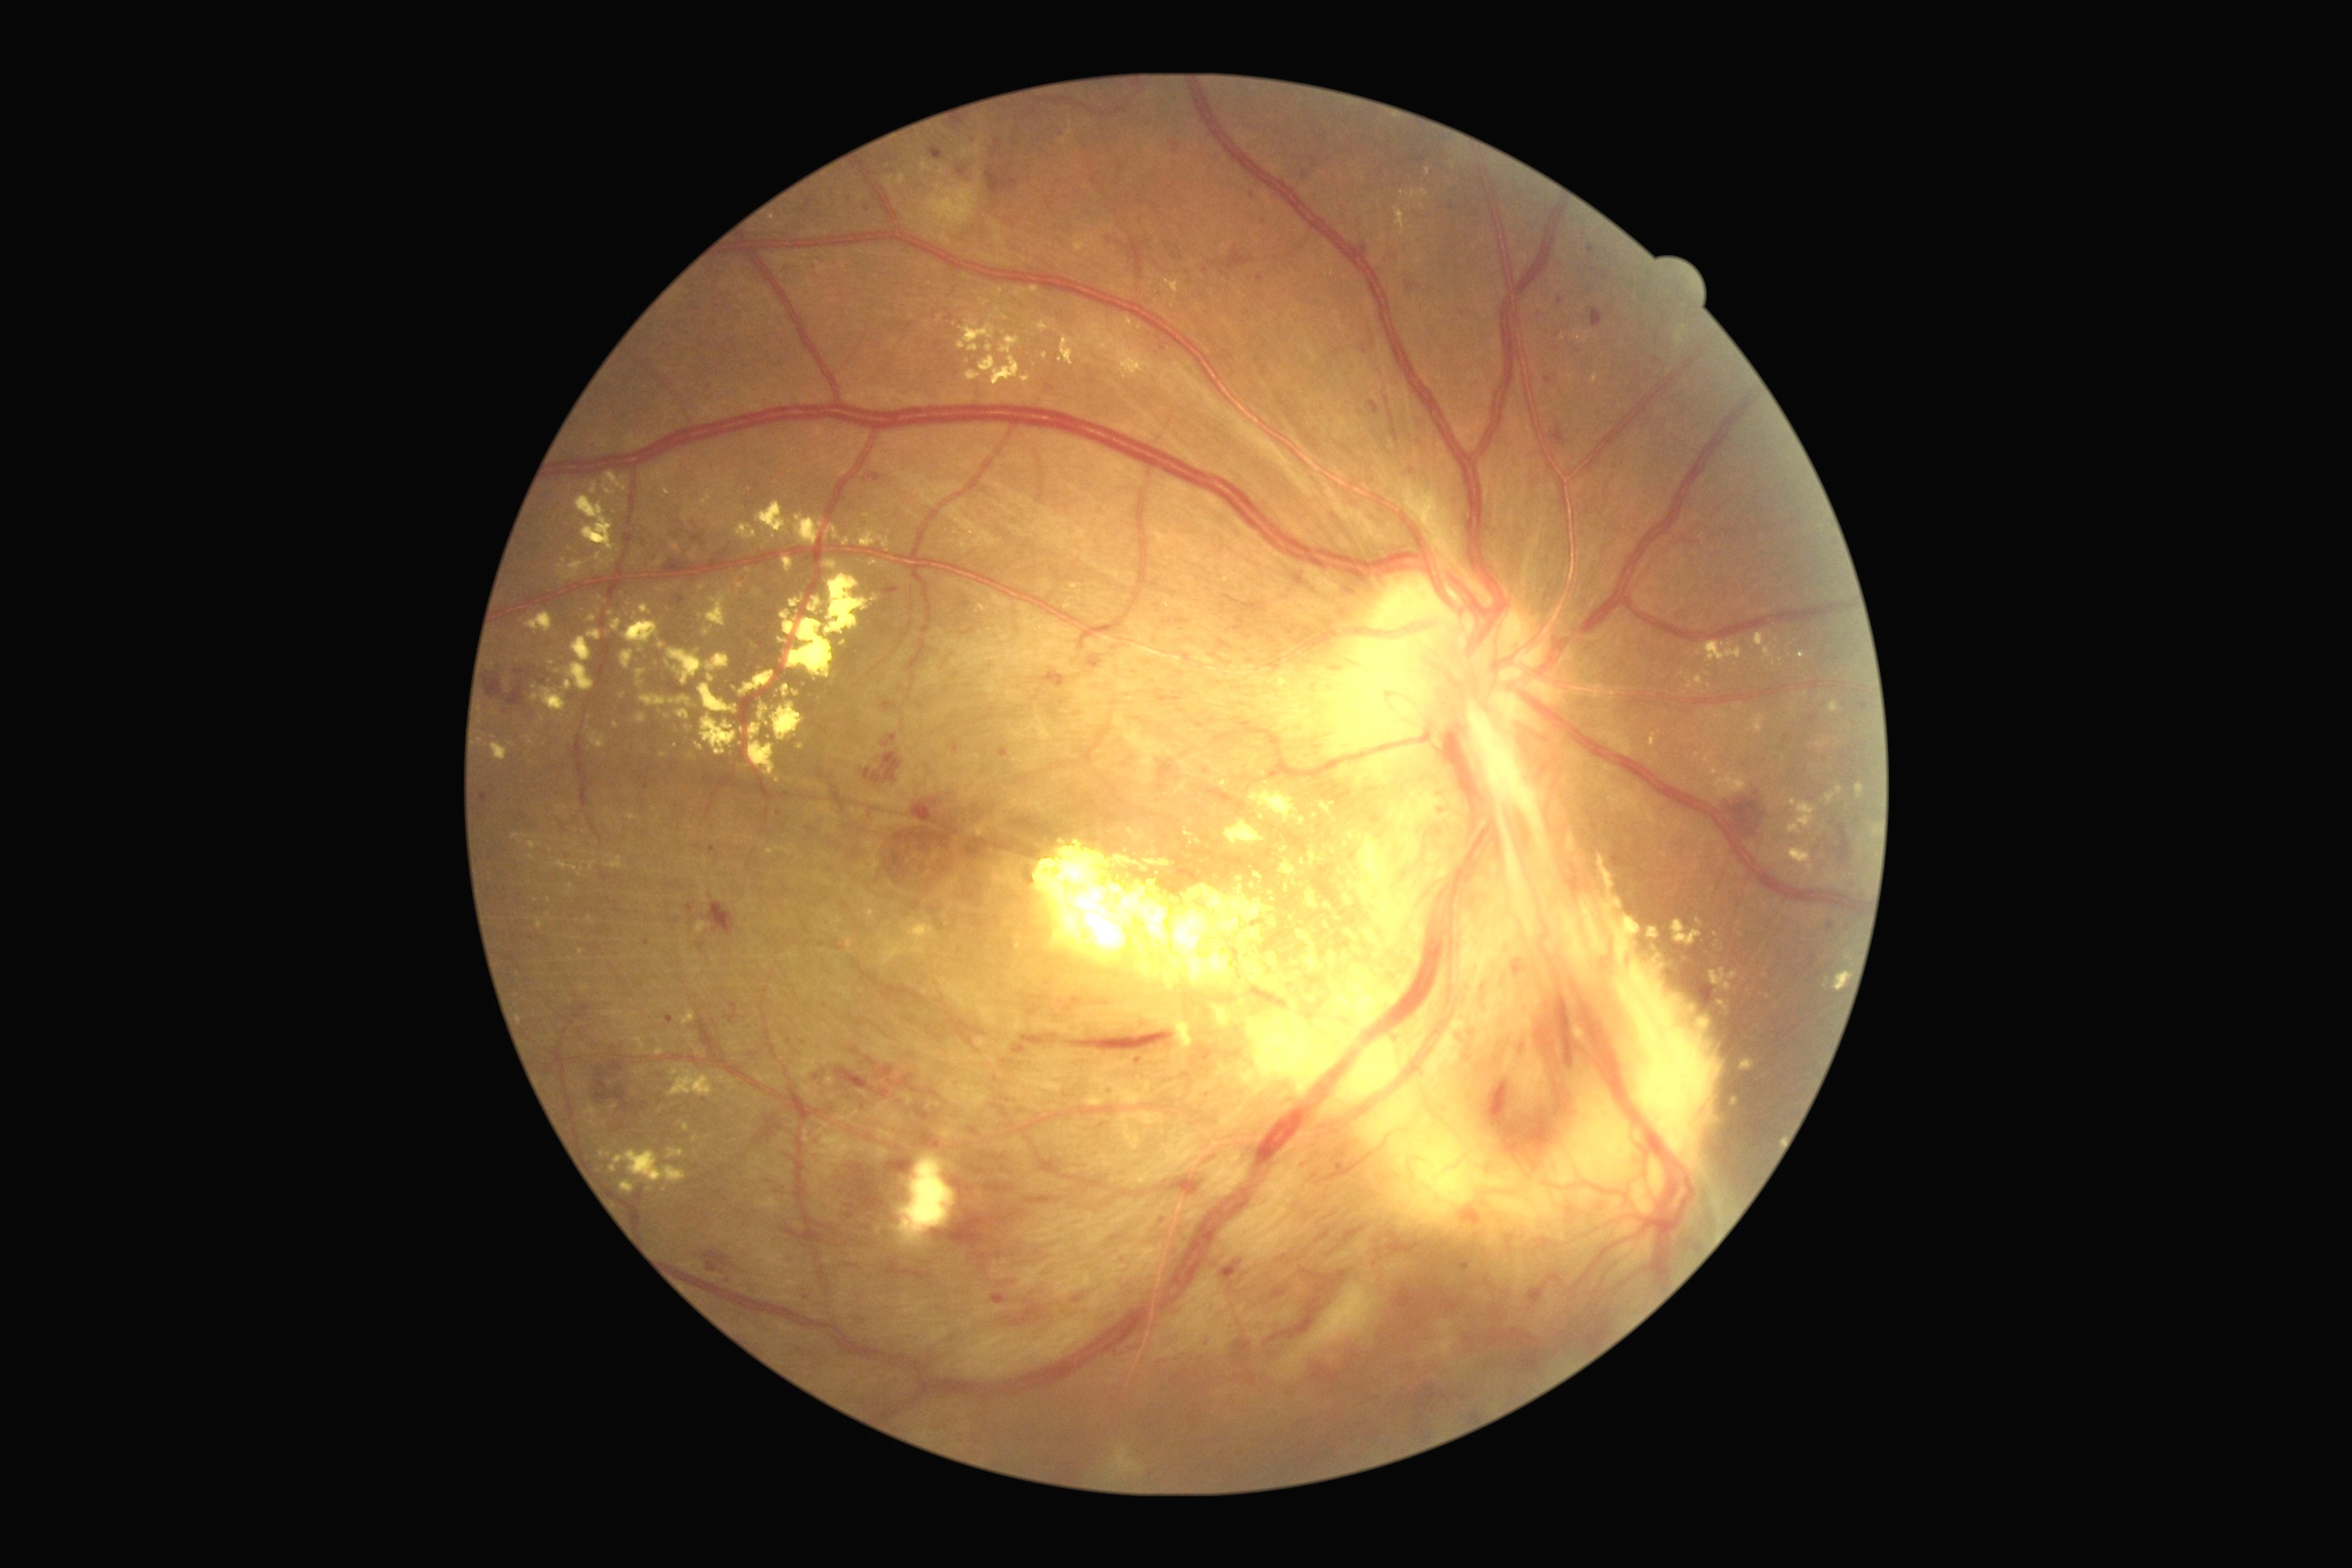
Diabetic retinopathy is grade 4 (PDR) — neovascularization and/or vitreous/pre-retinal hemorrhage
A subset of detected lesions:
hard exudates (continued) = (left=558, top=562, right=583, bottom=580) | (left=1269, top=676, right=1284, bottom=687) | (left=750, top=723, right=776, bottom=778) | (left=1255, top=872, right=1264, bottom=883) | (left=794, top=514, right=823, bottom=545) | (left=589, top=732, right=607, bottom=750) | (left=1799, top=652, right=1807, bottom=660) | (left=1119, top=366, right=1139, bottom=378) | (left=632, top=612, right=638, bottom=620) | (left=977, top=337, right=1032, bottom=387) | (left=827, top=525, right=839, bottom=540) | (left=536, top=919, right=544, bottom=930) | (left=529, top=841, right=544, bottom=850) | (left=1061, top=137, right=1070, bottom=144)
Smaller hard exudates around 968, 362 | 1240, 880 | 1849, 959 | 1140, 327 | 668, 717